Acquired with a Topcon TRC-NW8 · macula-centered field: 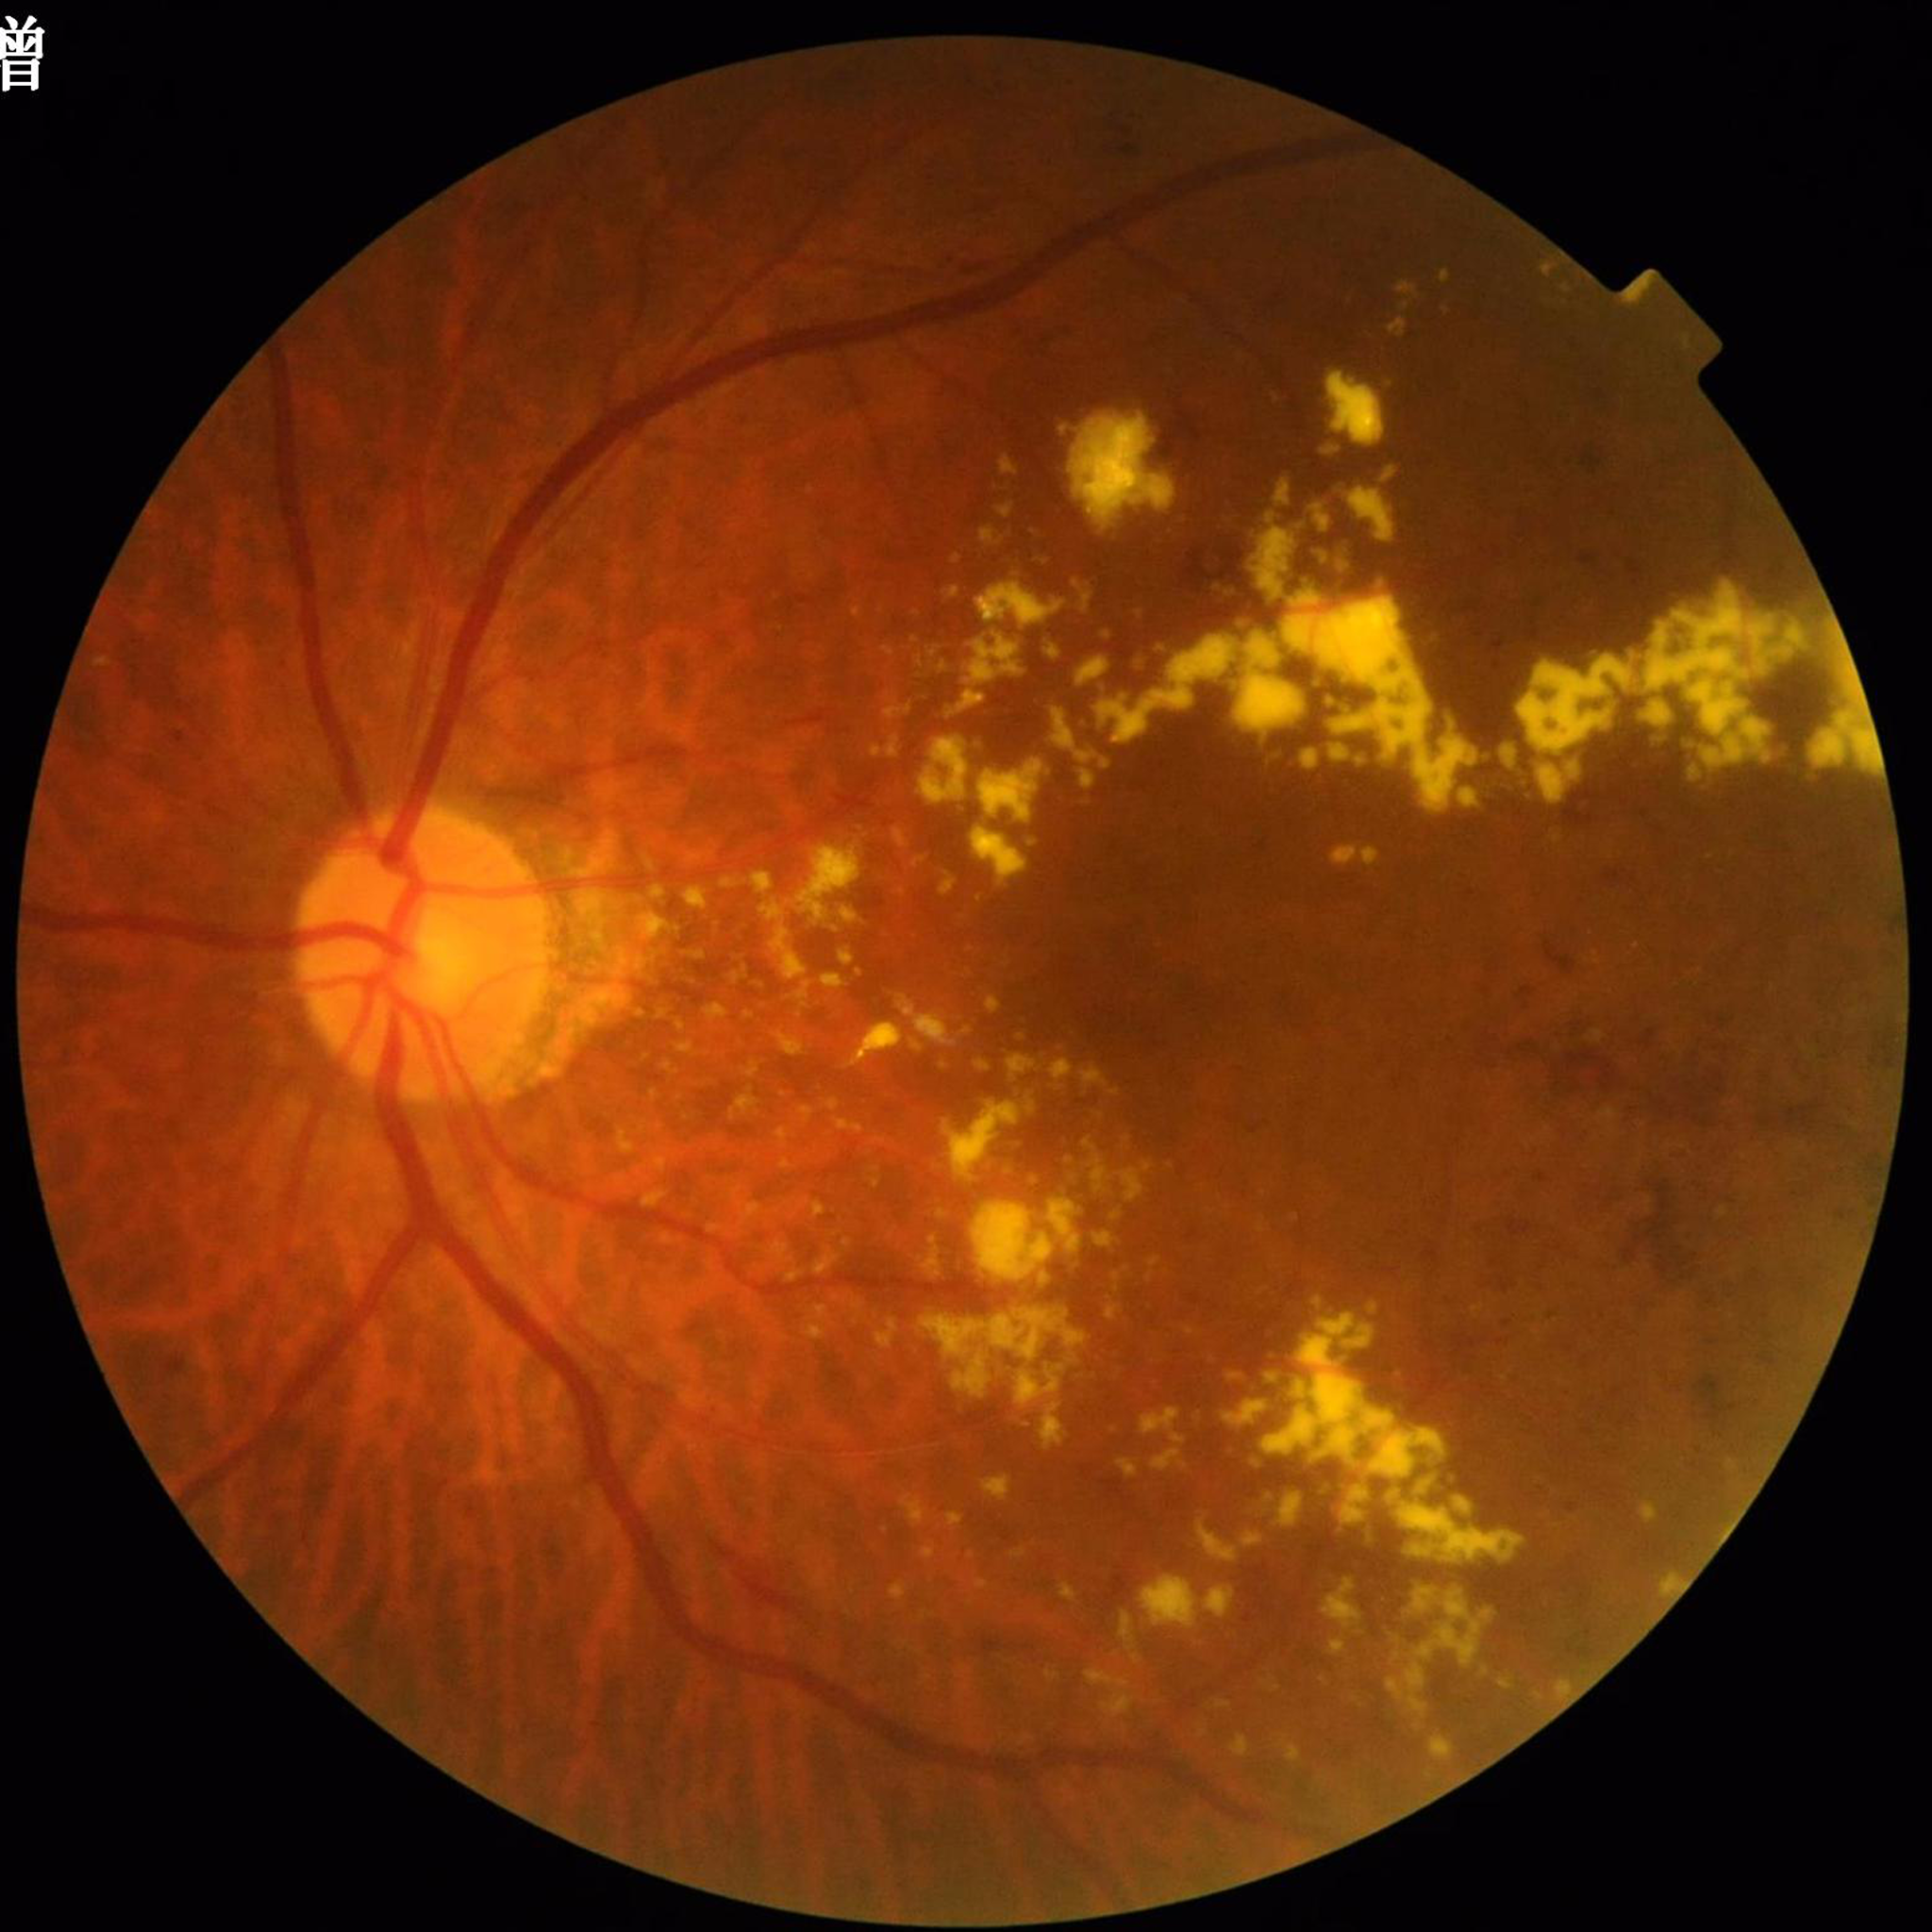 The patient was diagnosed with DR.